NIDEK AFC-230 fundus camera
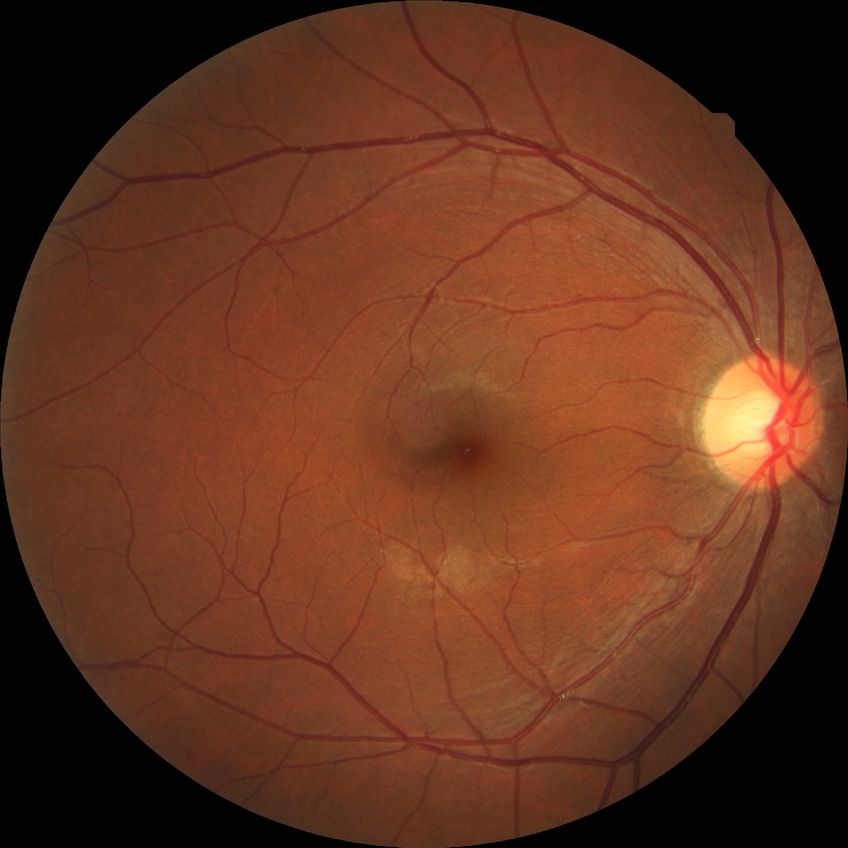

diabetic retinopathy (DR) = no diabetic retinopathy (NDR)